2352 by 1568 pixels. 45-degree field of view. Fundus photo — 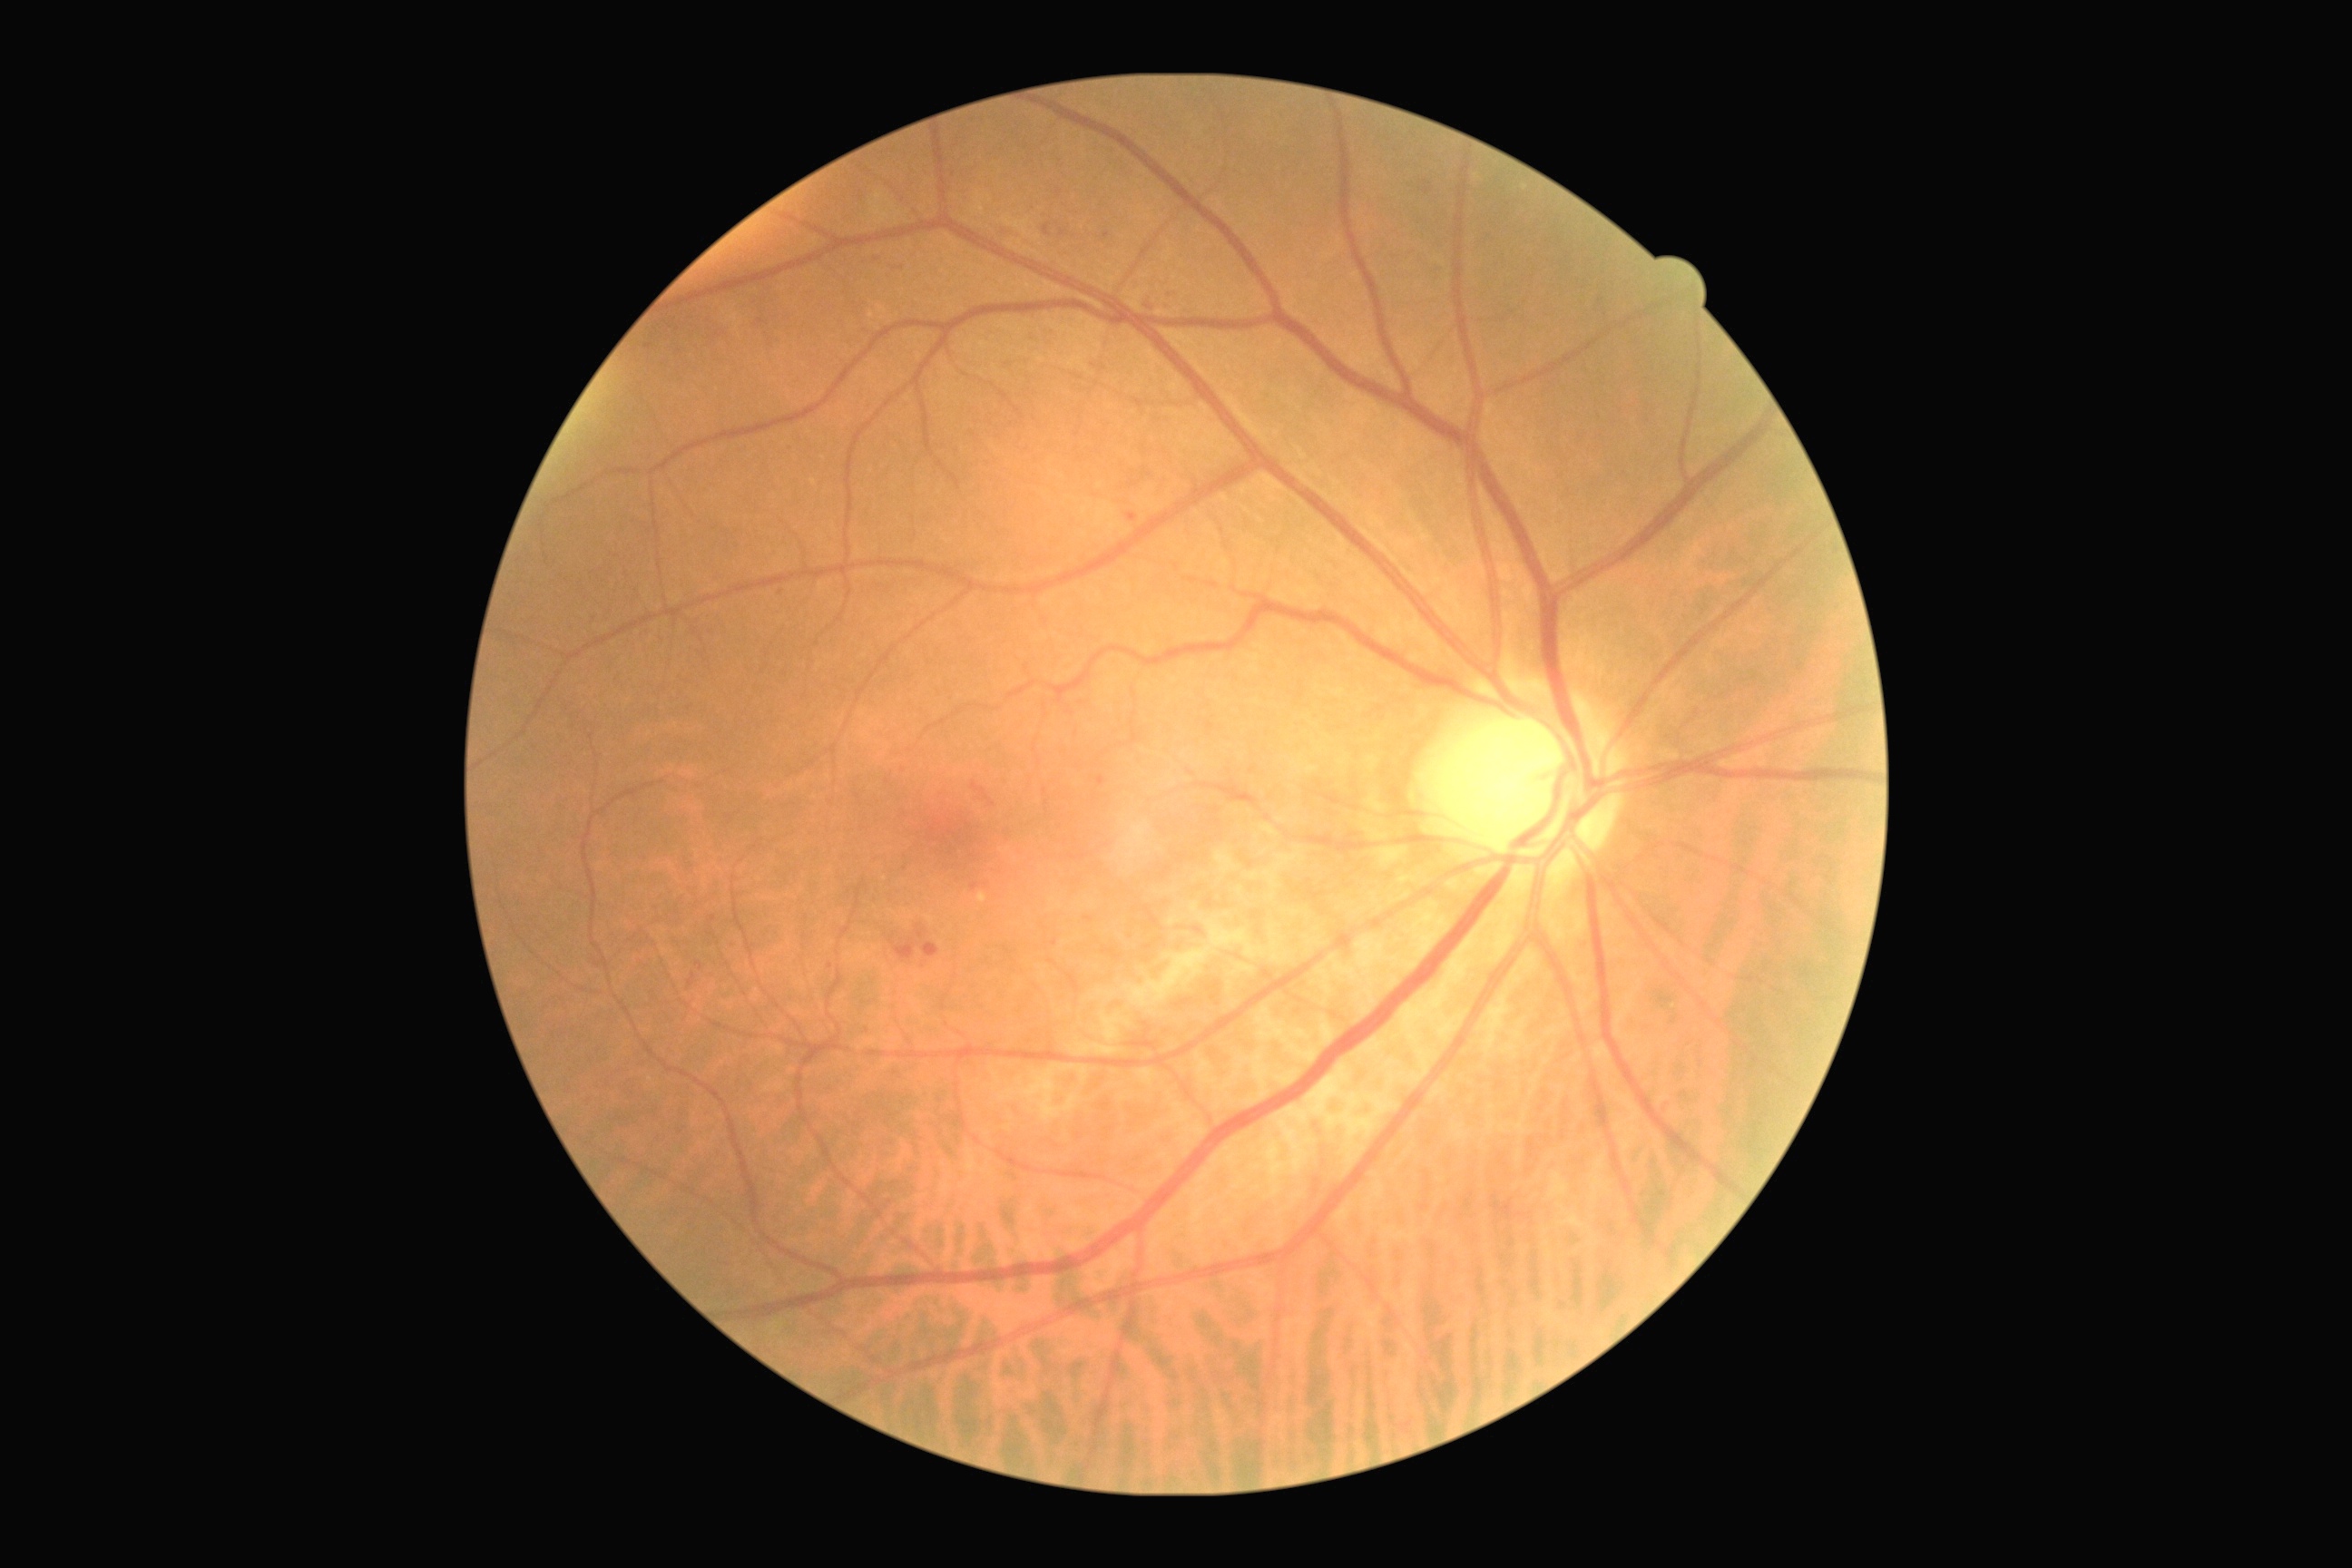

Disease class: non-proliferative diabetic retinopathy.
Diabetic retinopathy (DR) is grade 2 (moderate NPDR).